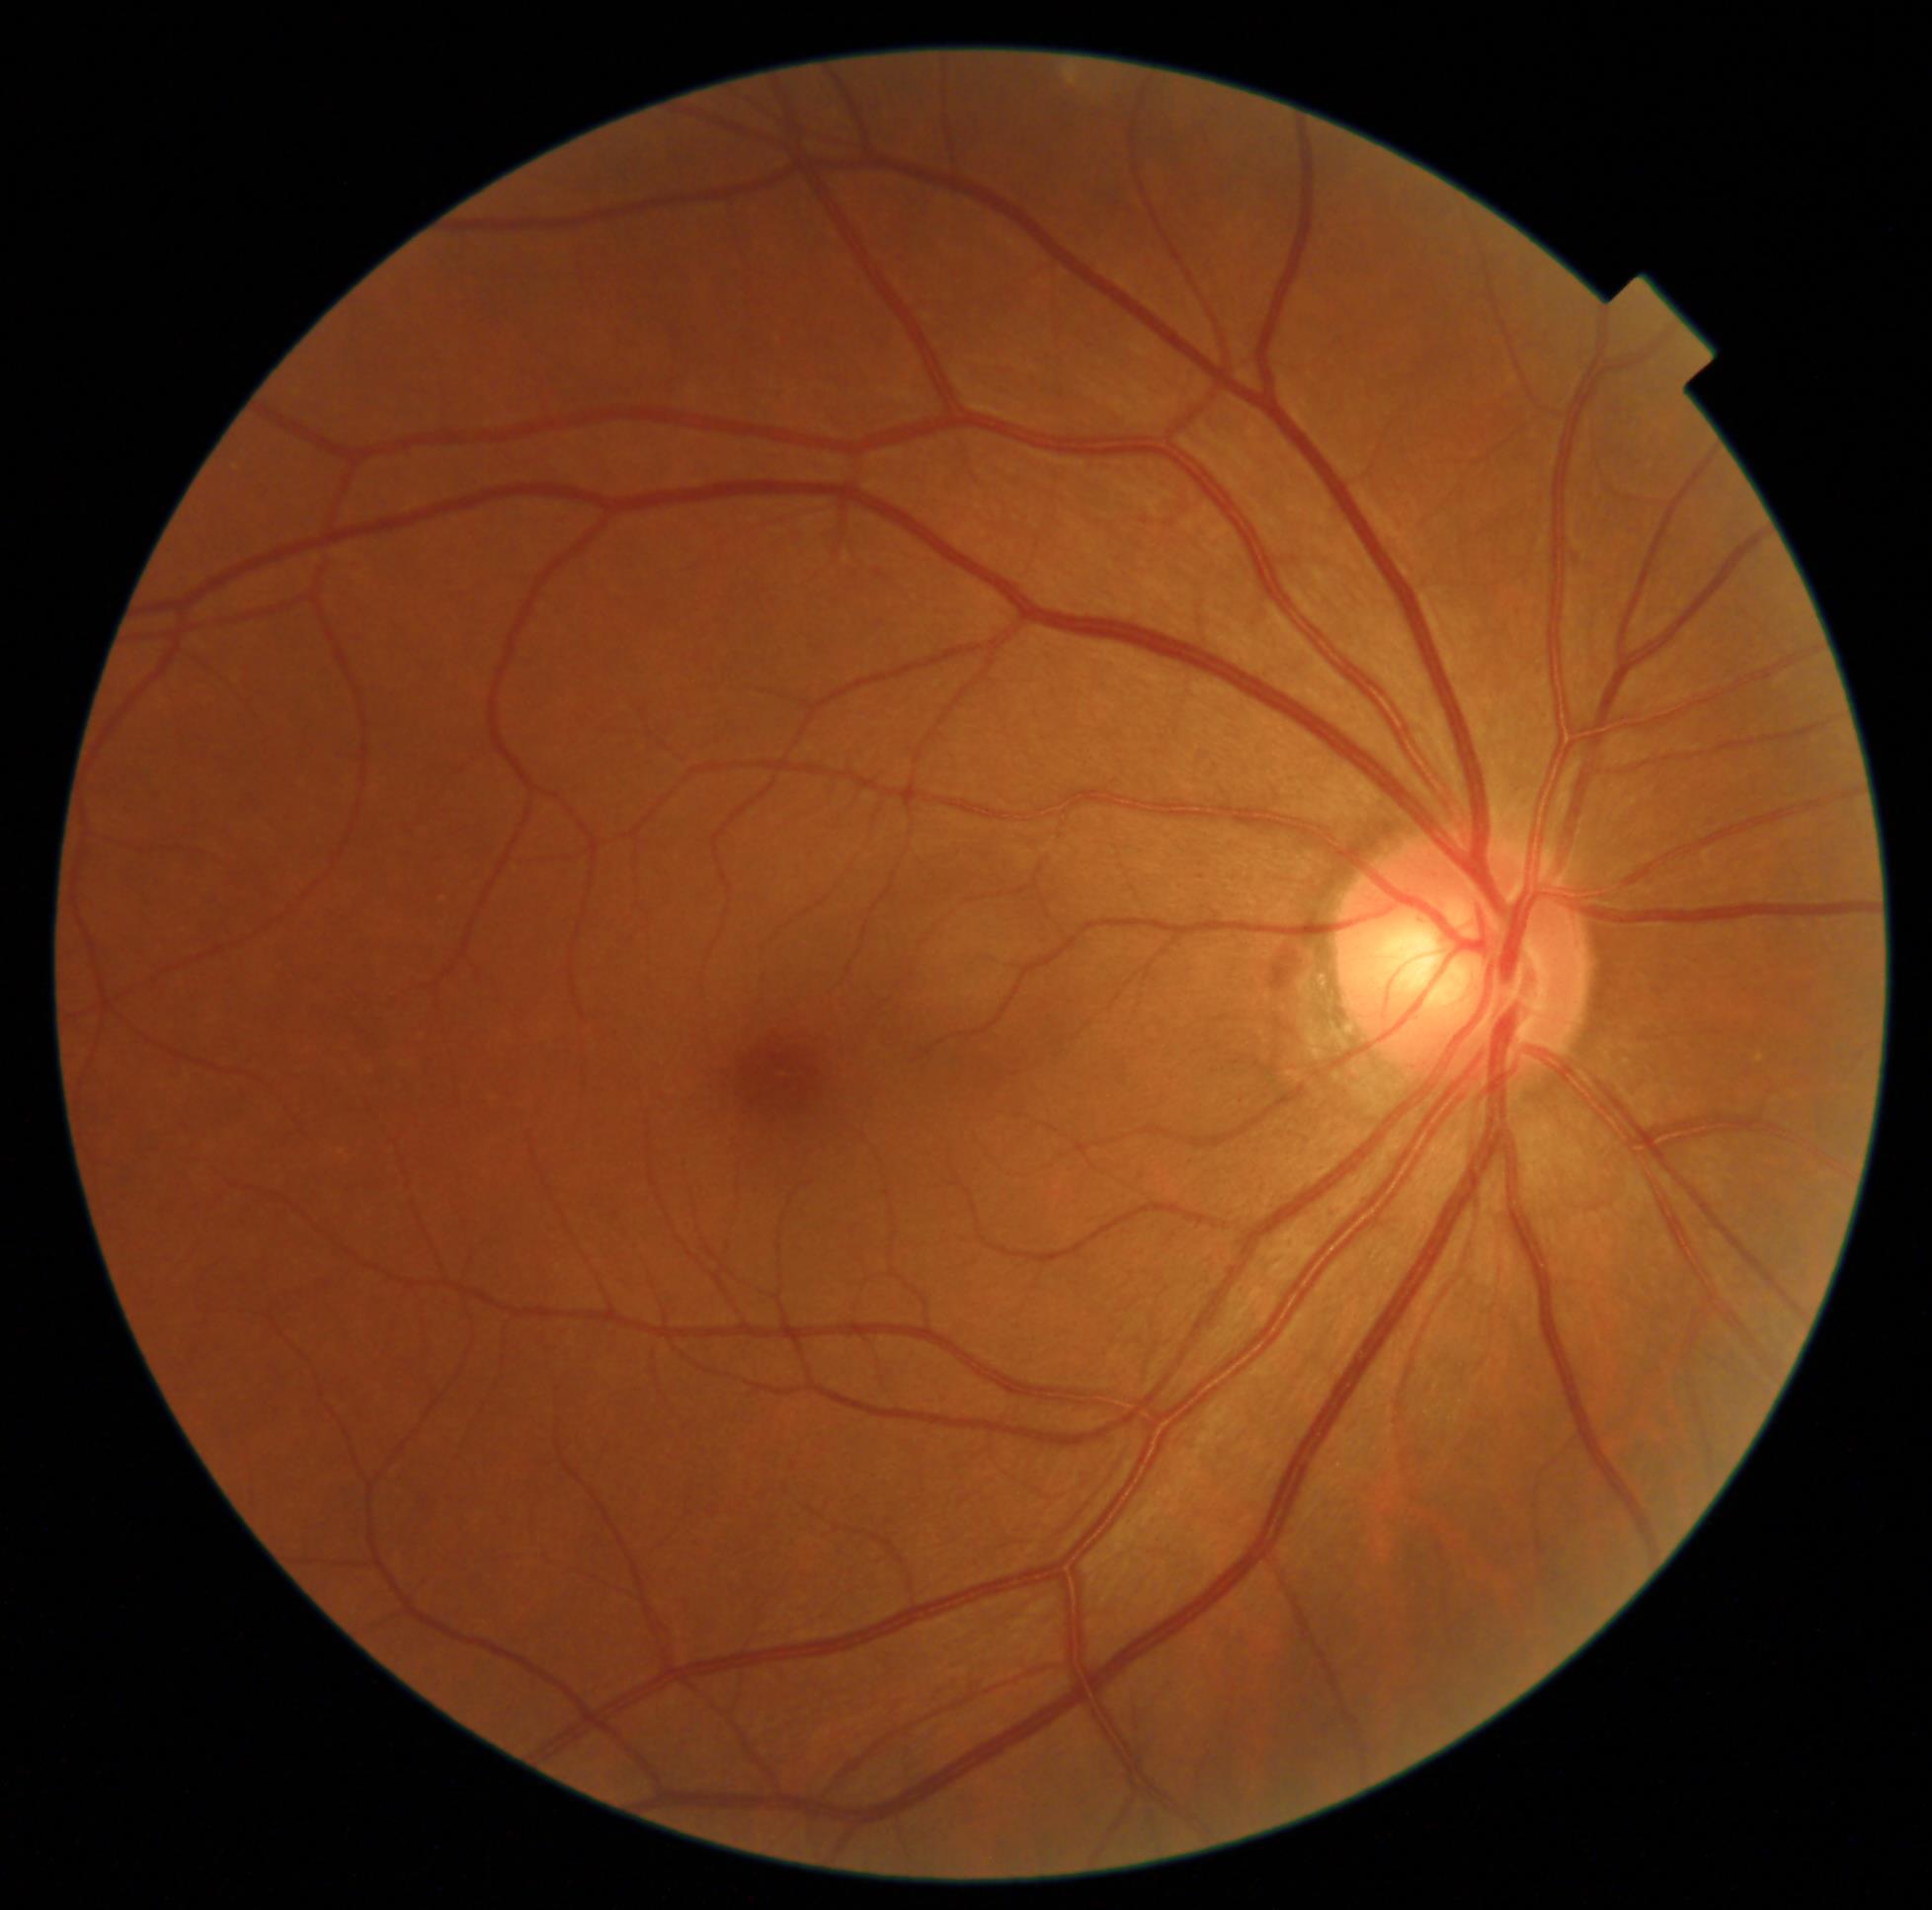

dr_grade: grade 0